848x848; posterior pole photograph
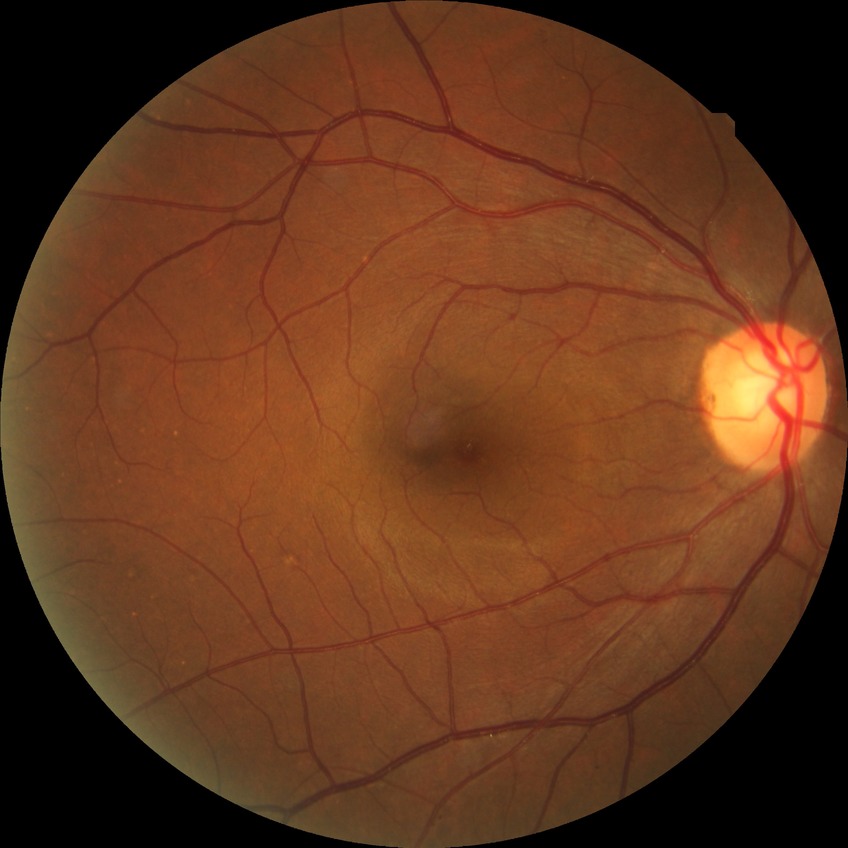 Diabetic retinopathy (DR) is NDR (no diabetic retinopathy).